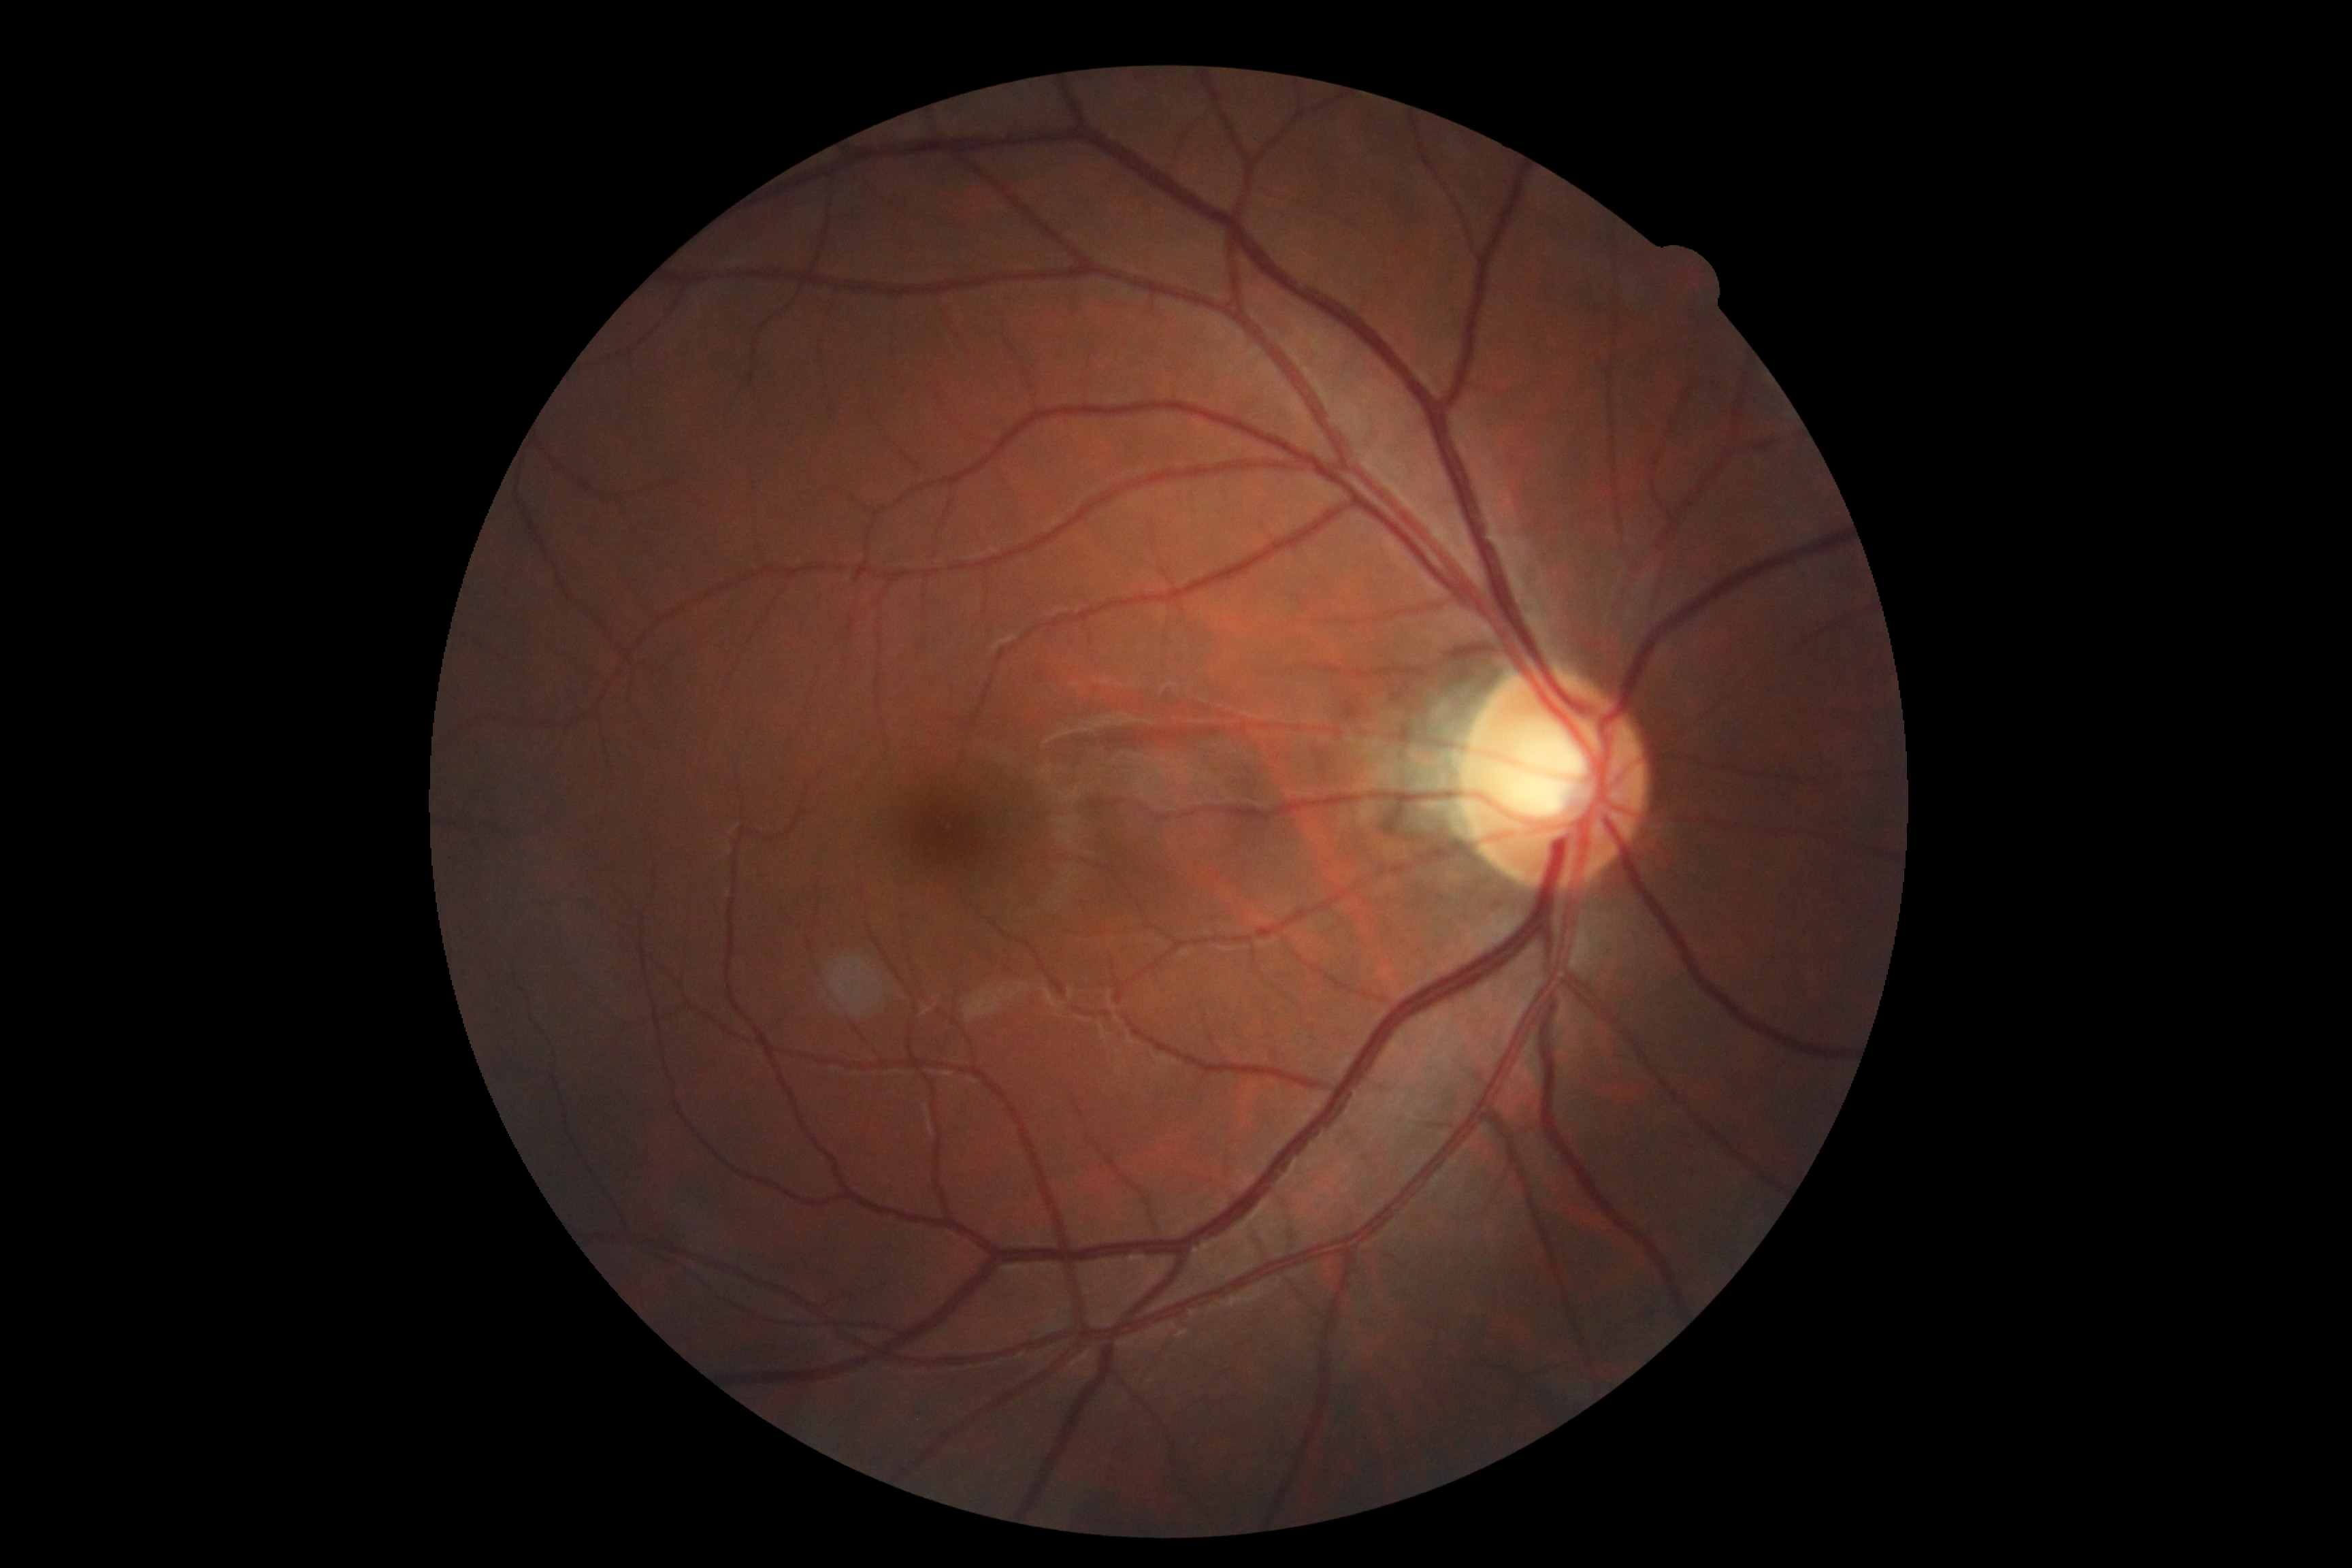 diabetic retinopathy (DR)=0.